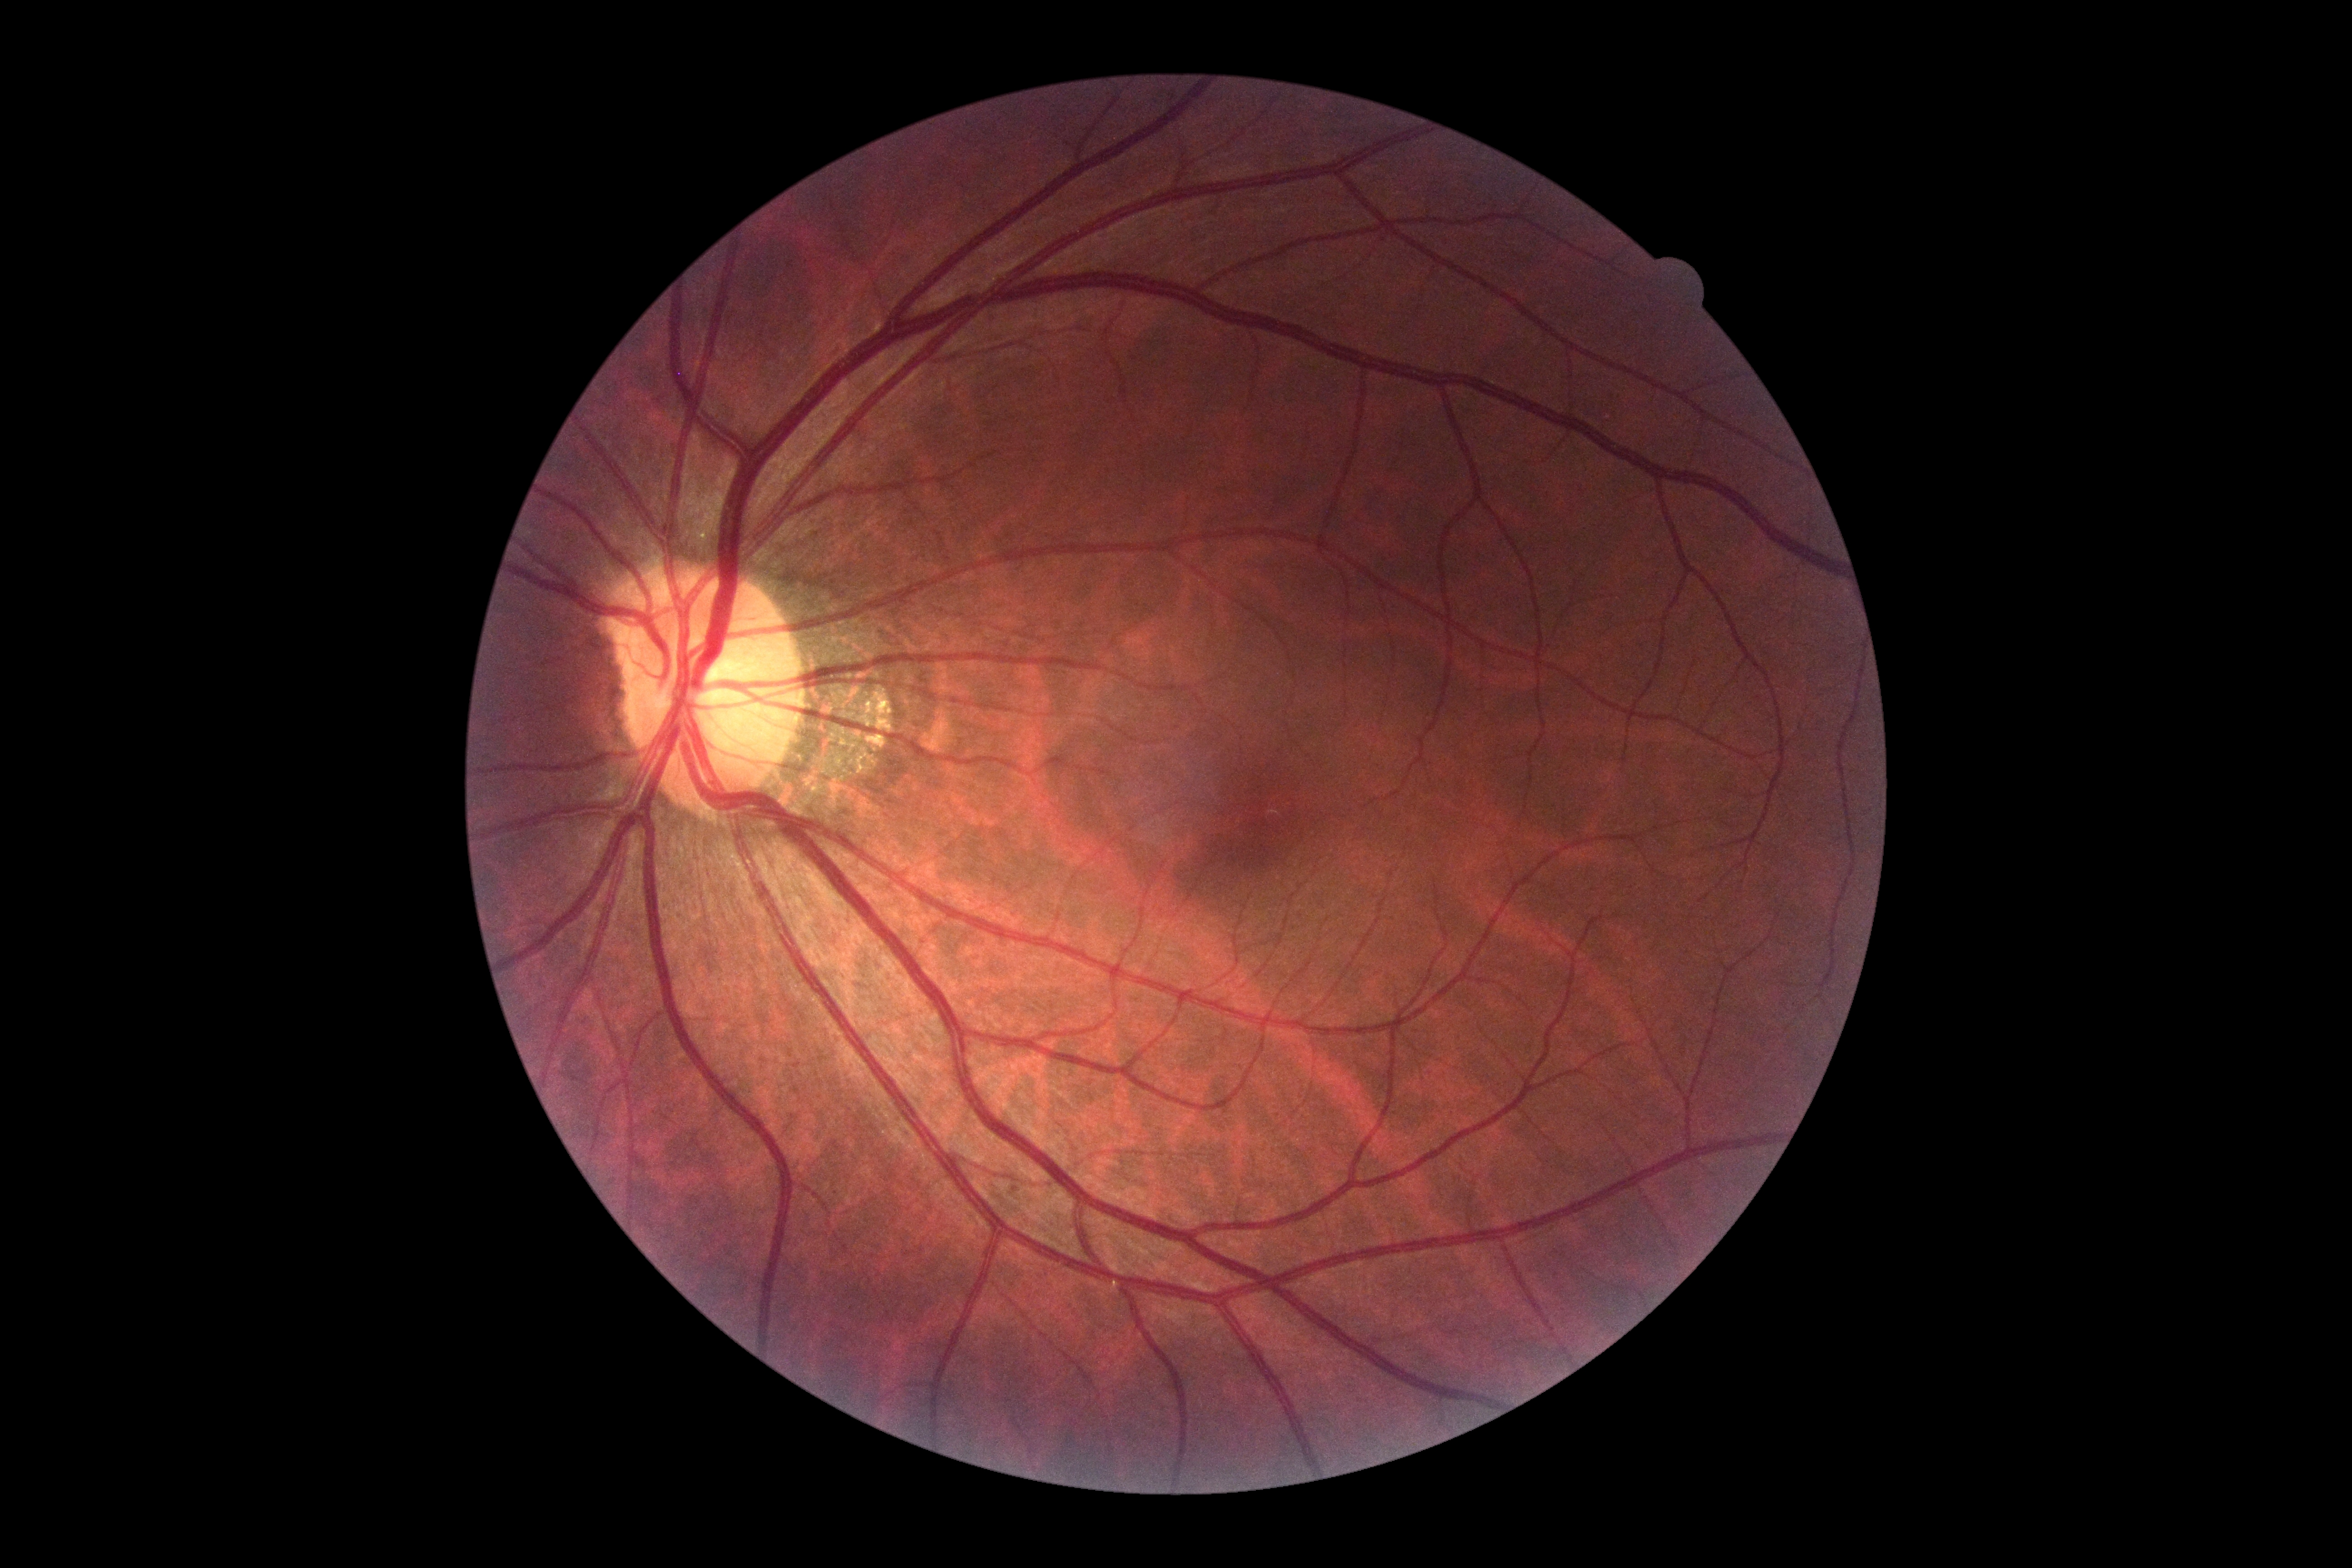

DR is grade 0 — no visible signs of diabetic retinopathy.